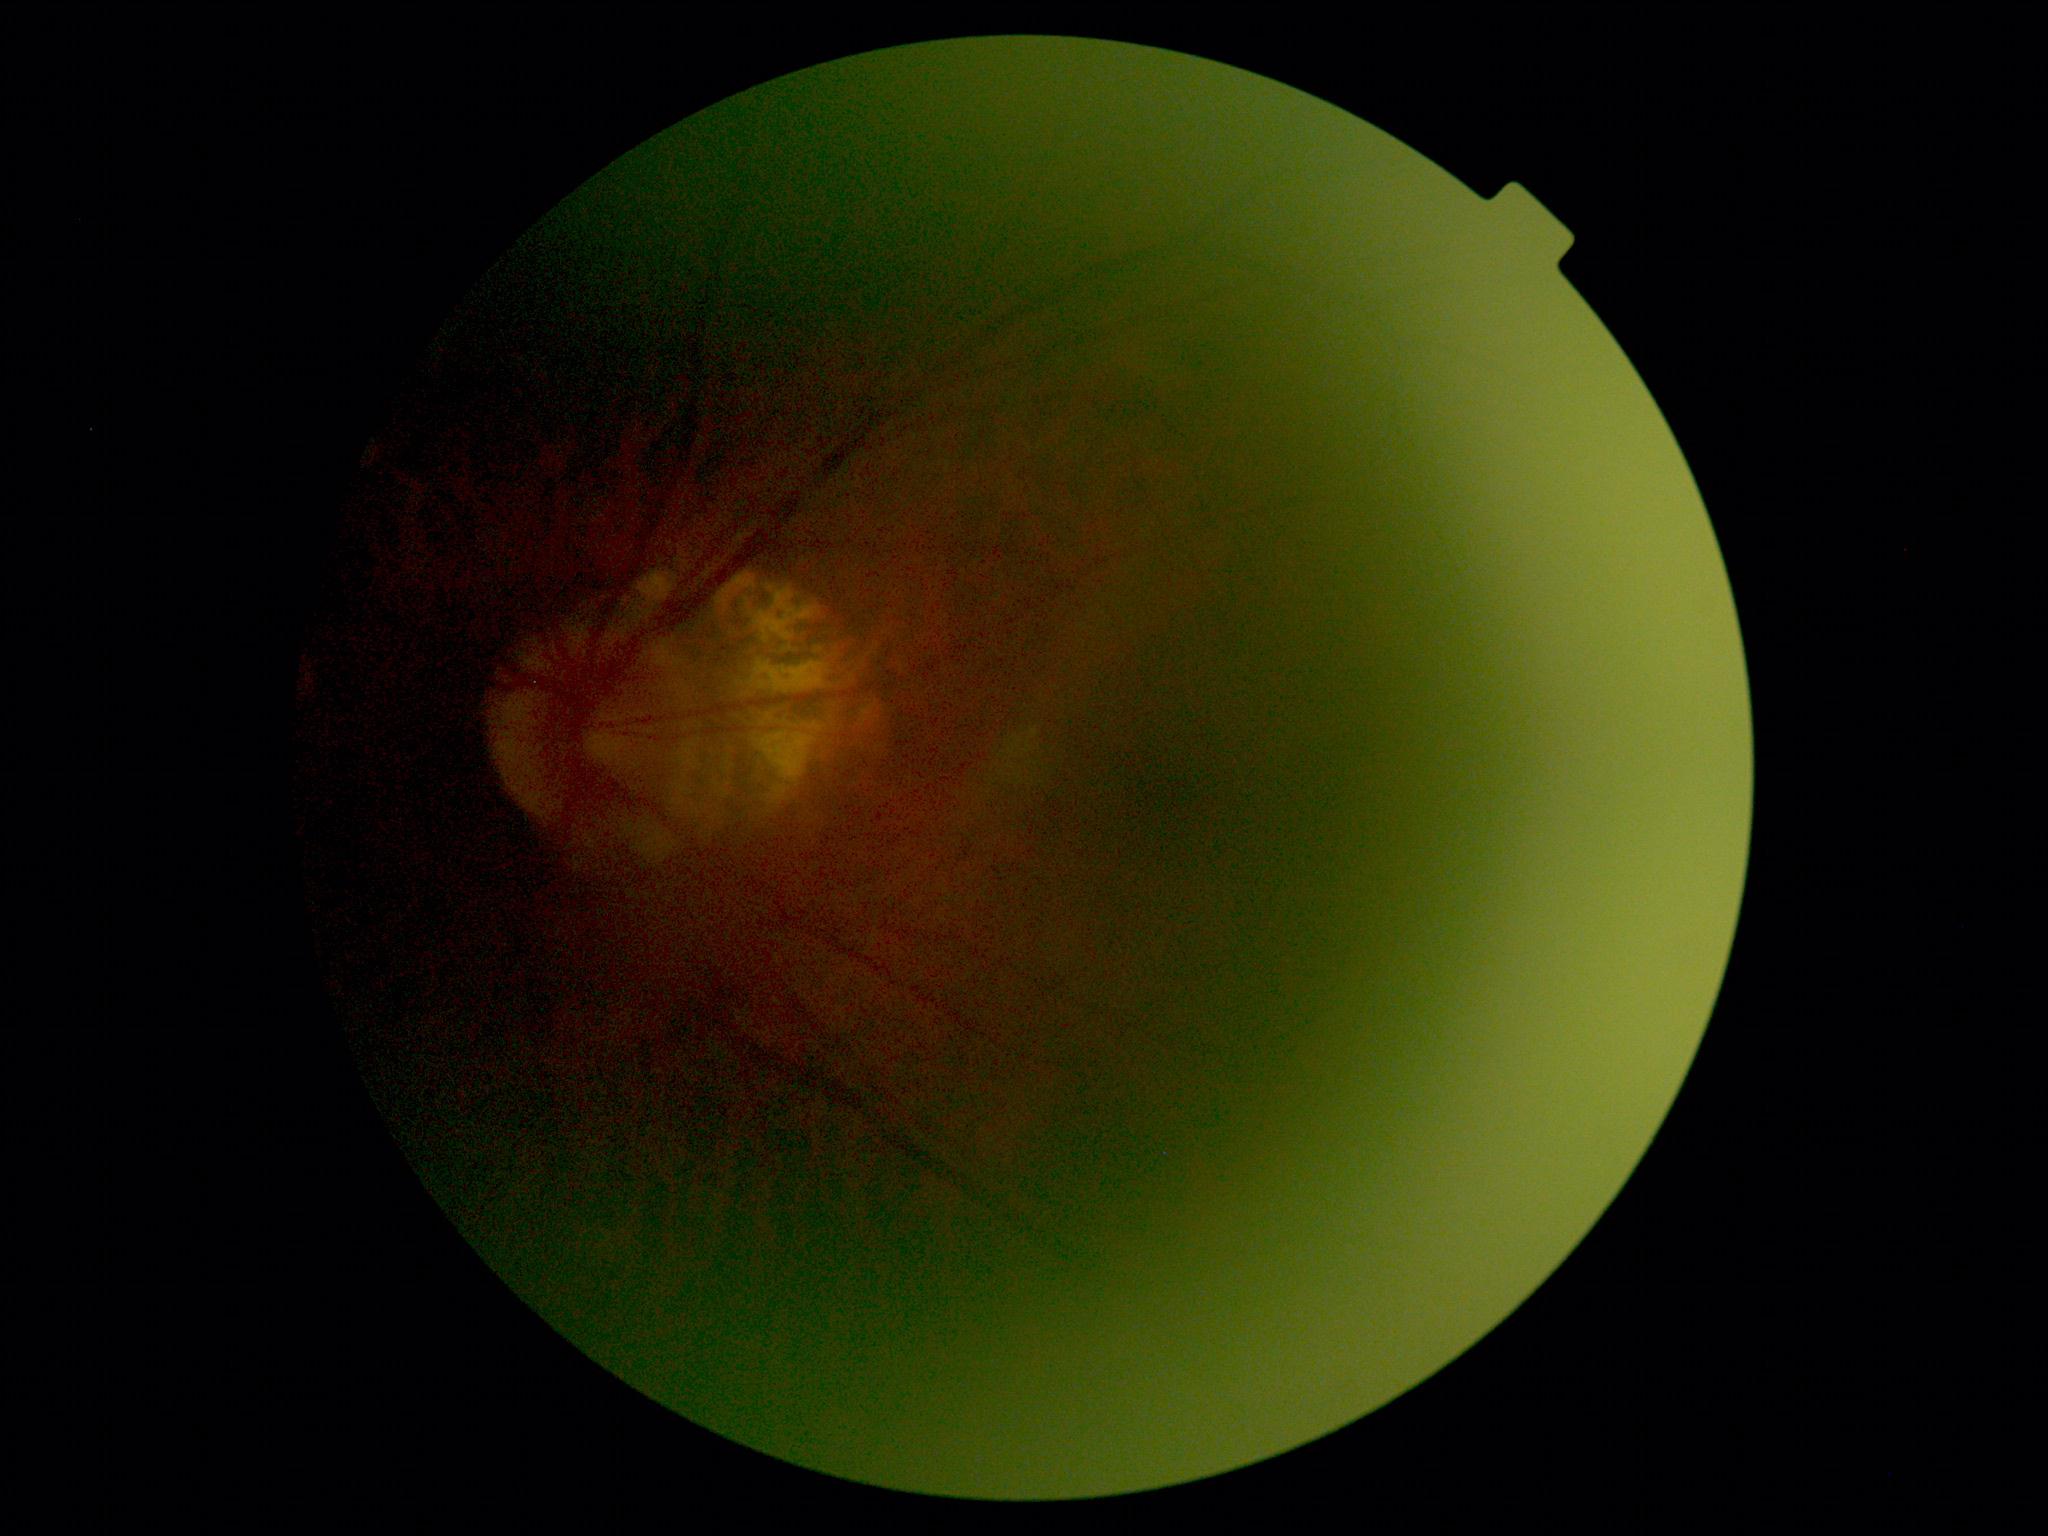
Findings:
• DR severity: ungradable due to poor image quality
• image quality: below grading threshold